848 by 848 pixels
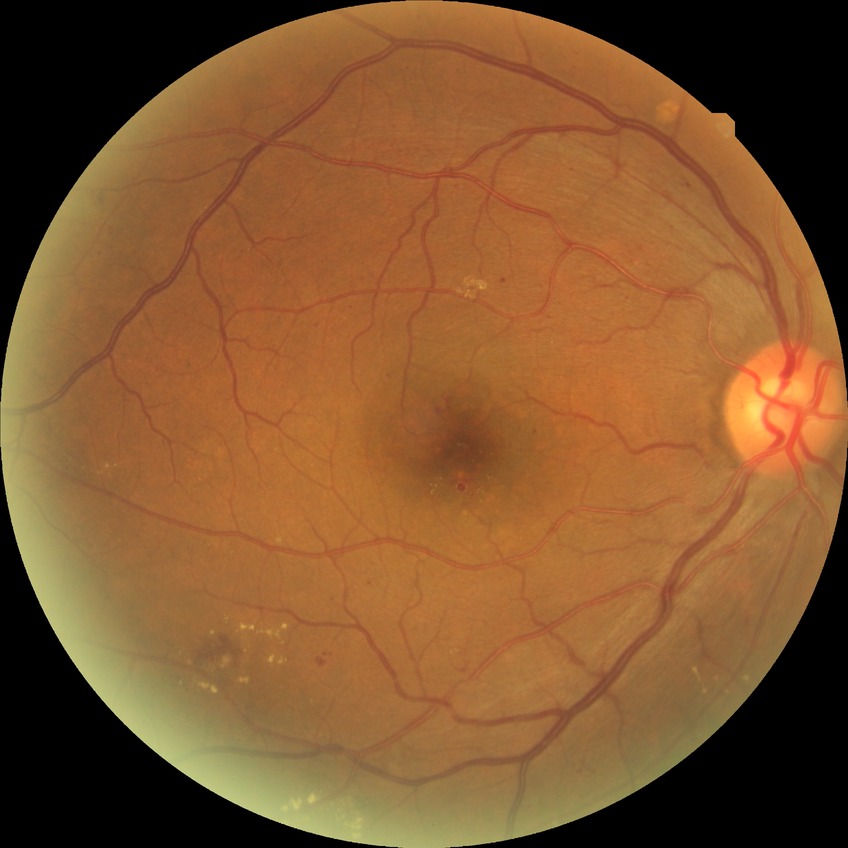
Diabetic retinopathy (DR) is SDR (simple diabetic retinopathy).